Sex: female; patient age: 34 years; axial length (AL) 21.87 mm; intraocular pressure (pneumatic tonometry): 21 mmHg; corneal thickness: 470 µm.
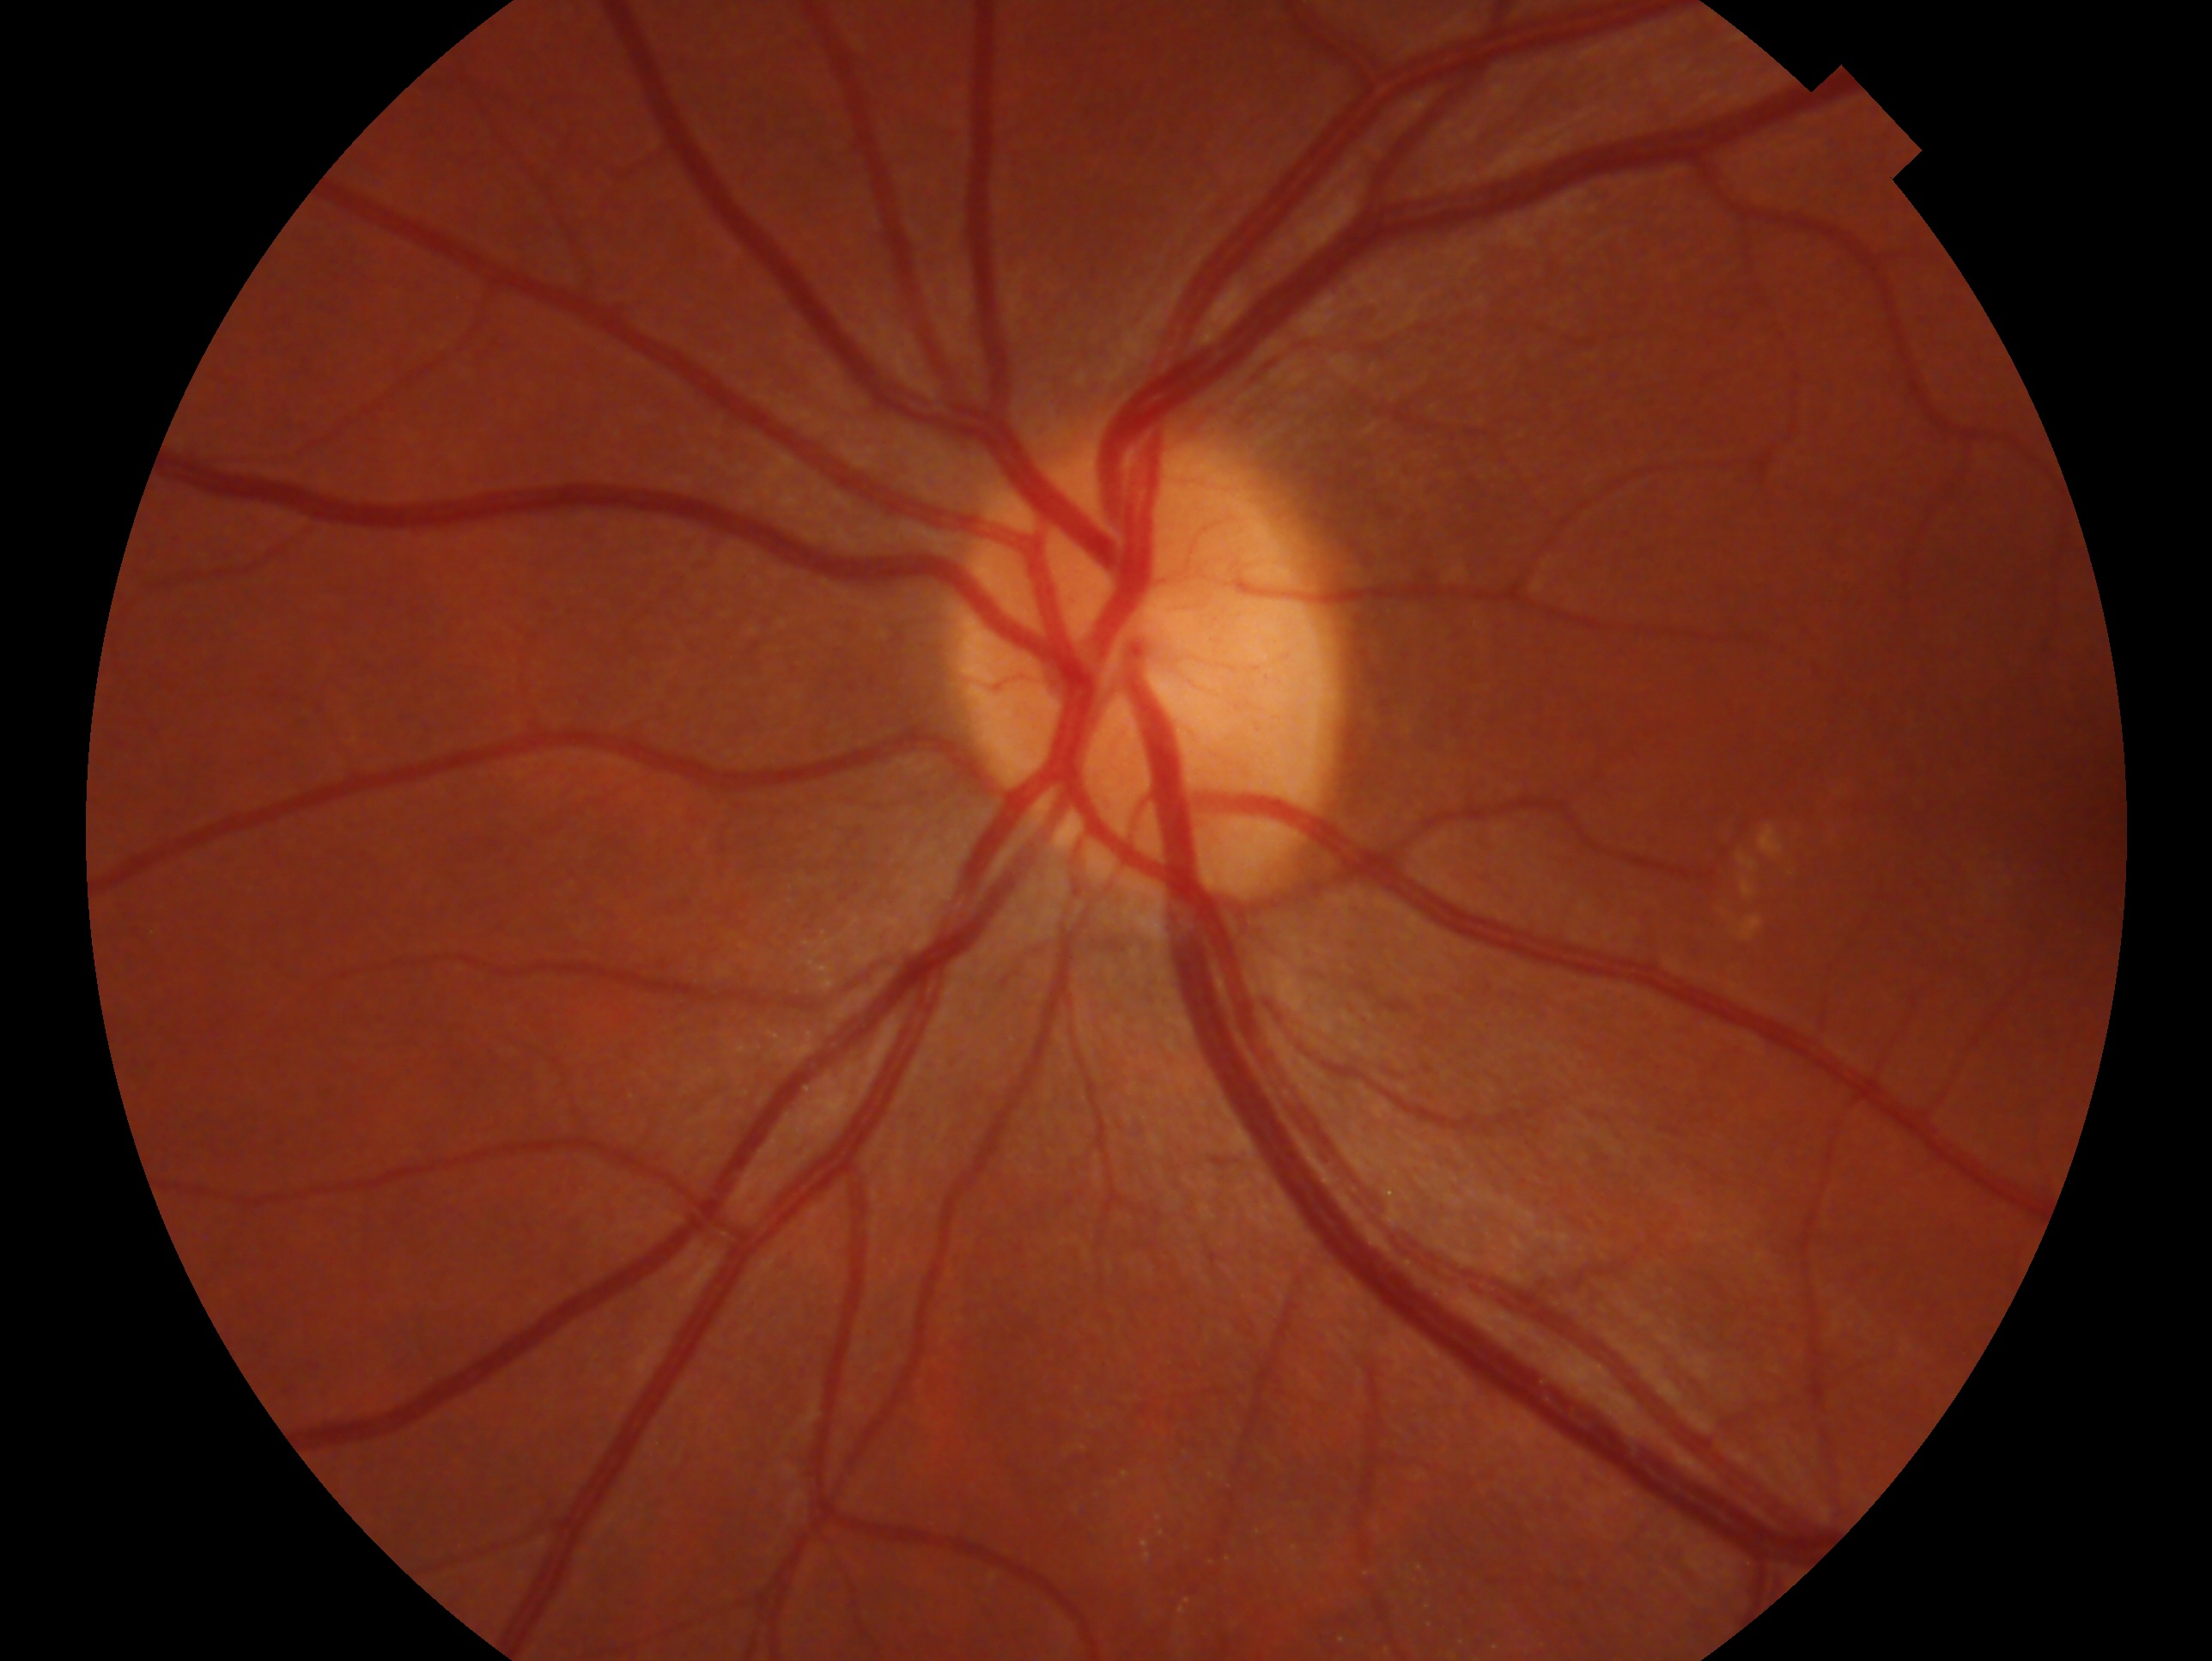 laterality: oculus sinister | diagnosis: no evidence of glaucoma.